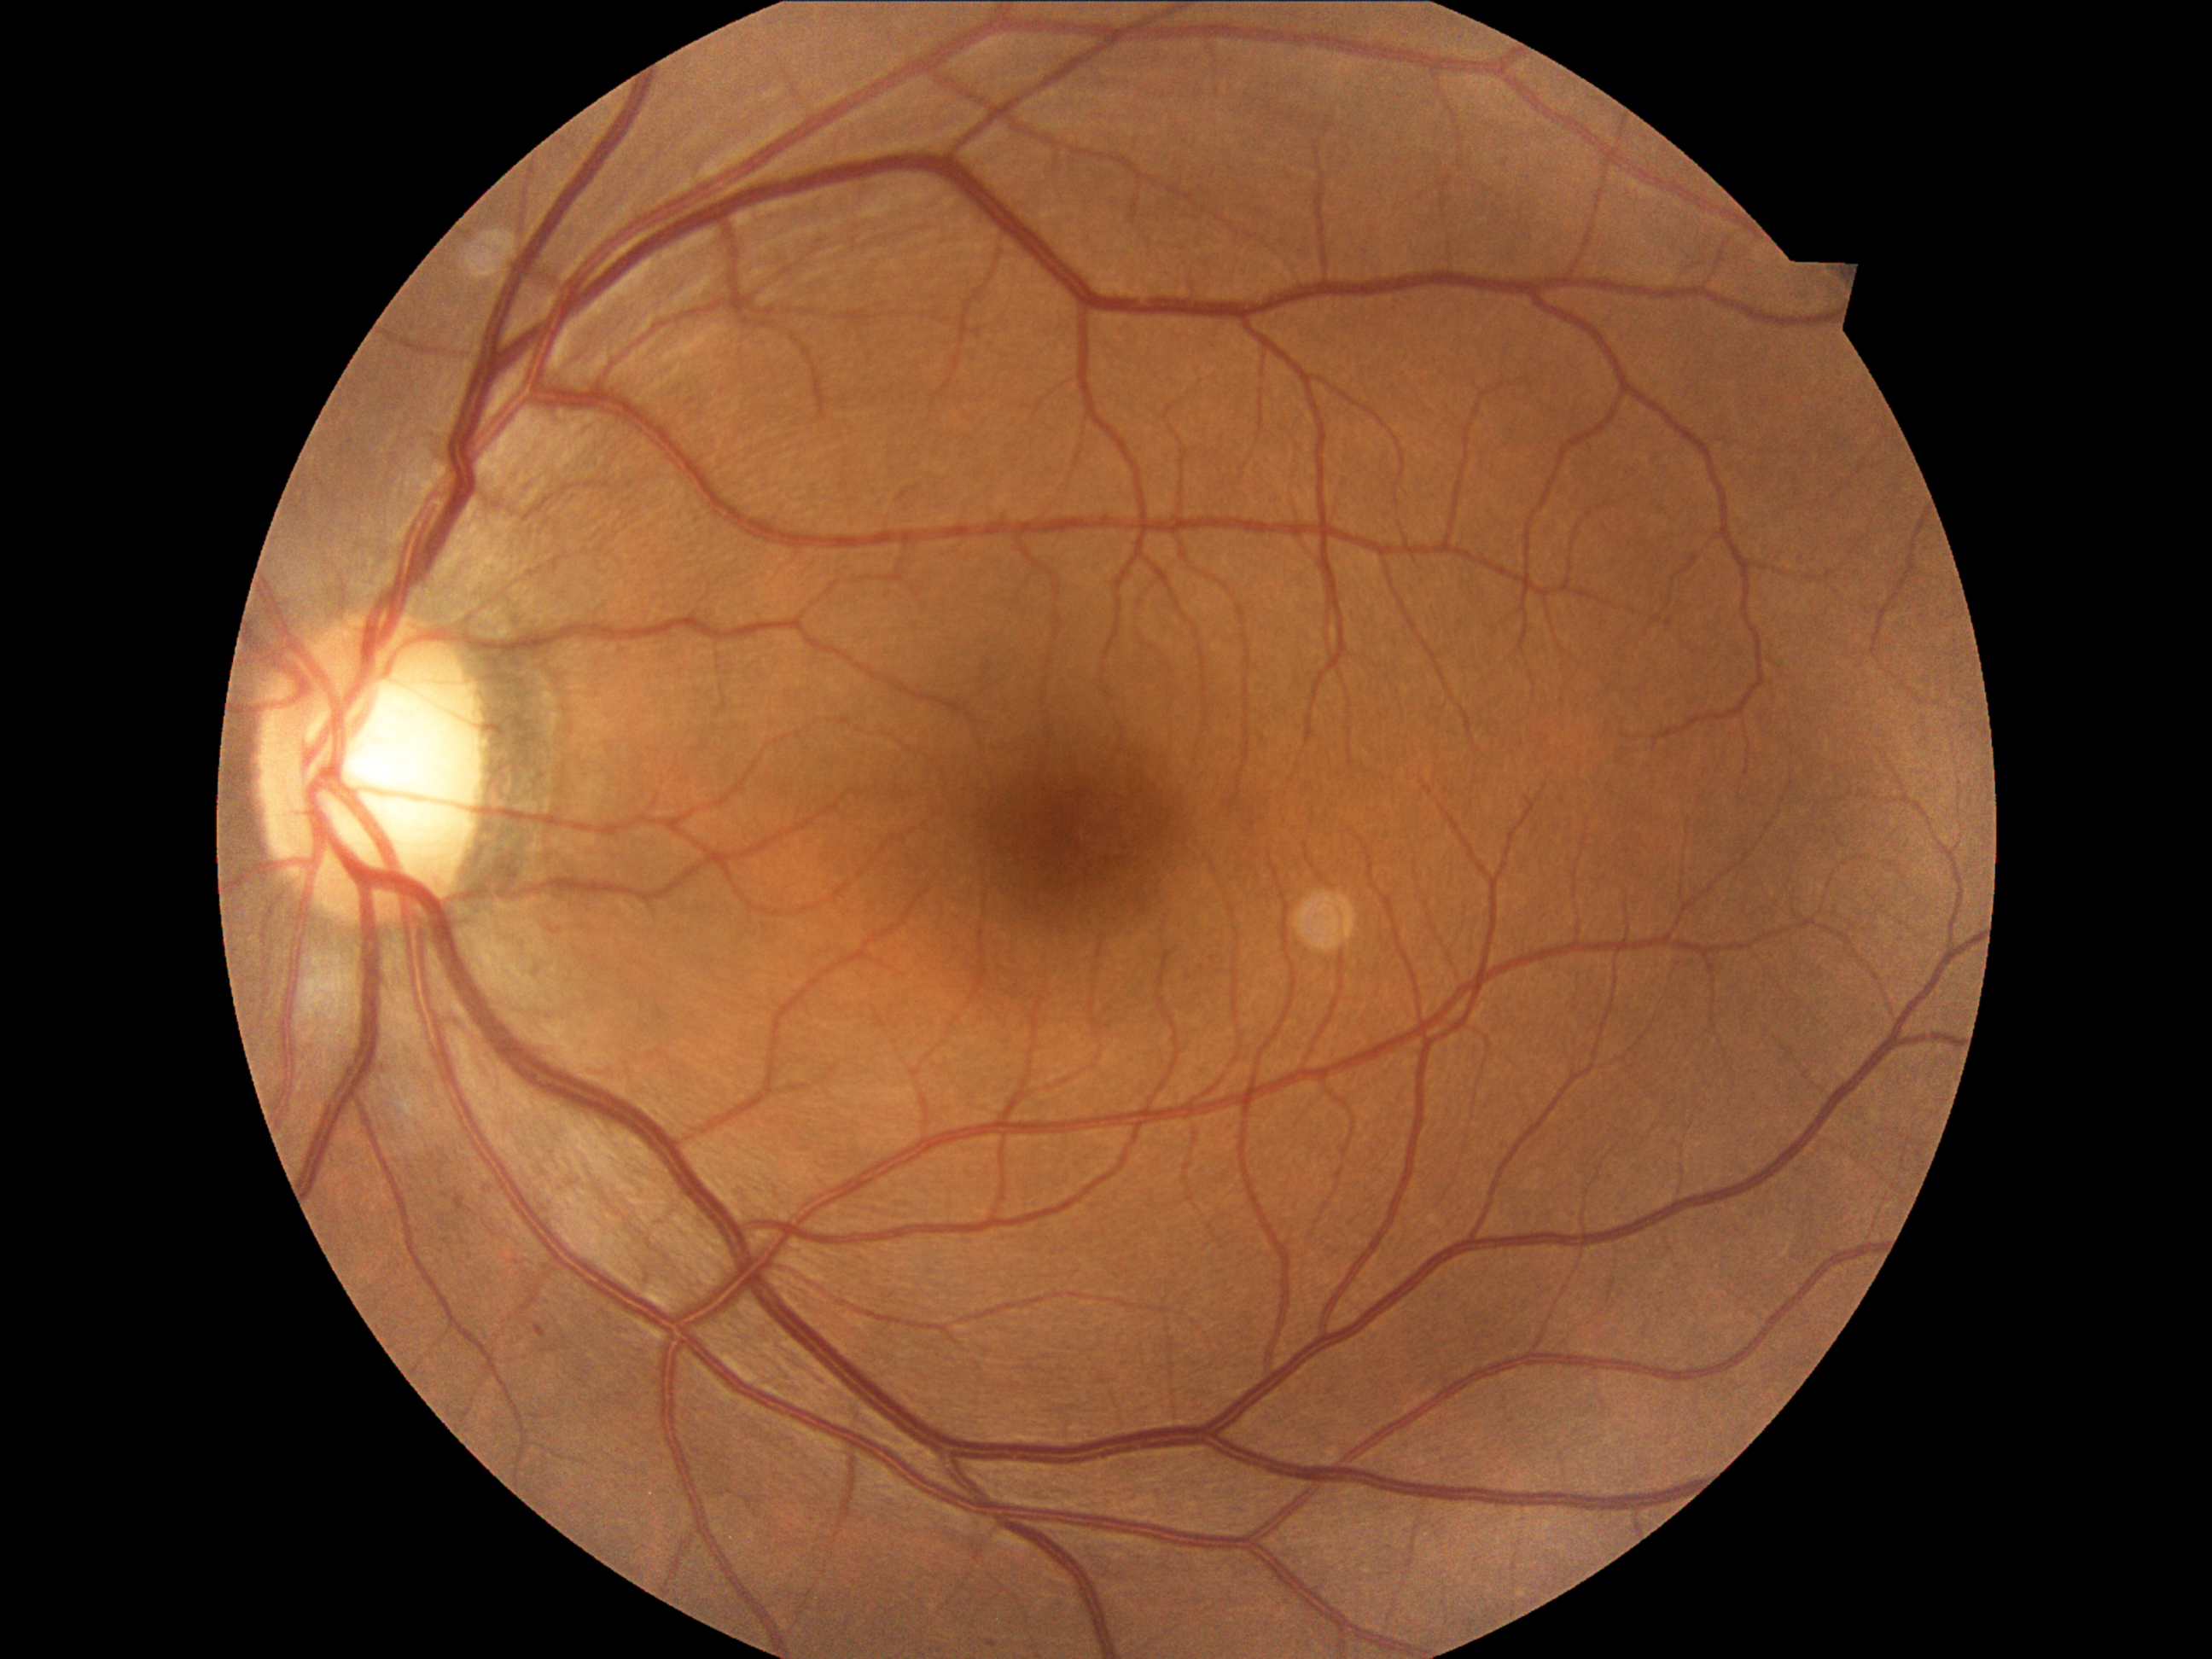 DR severity: grade 1 (mild NPDR).
DR class: non-proliferative diabetic retinopathy.